Image size 1659x2212. CFP — 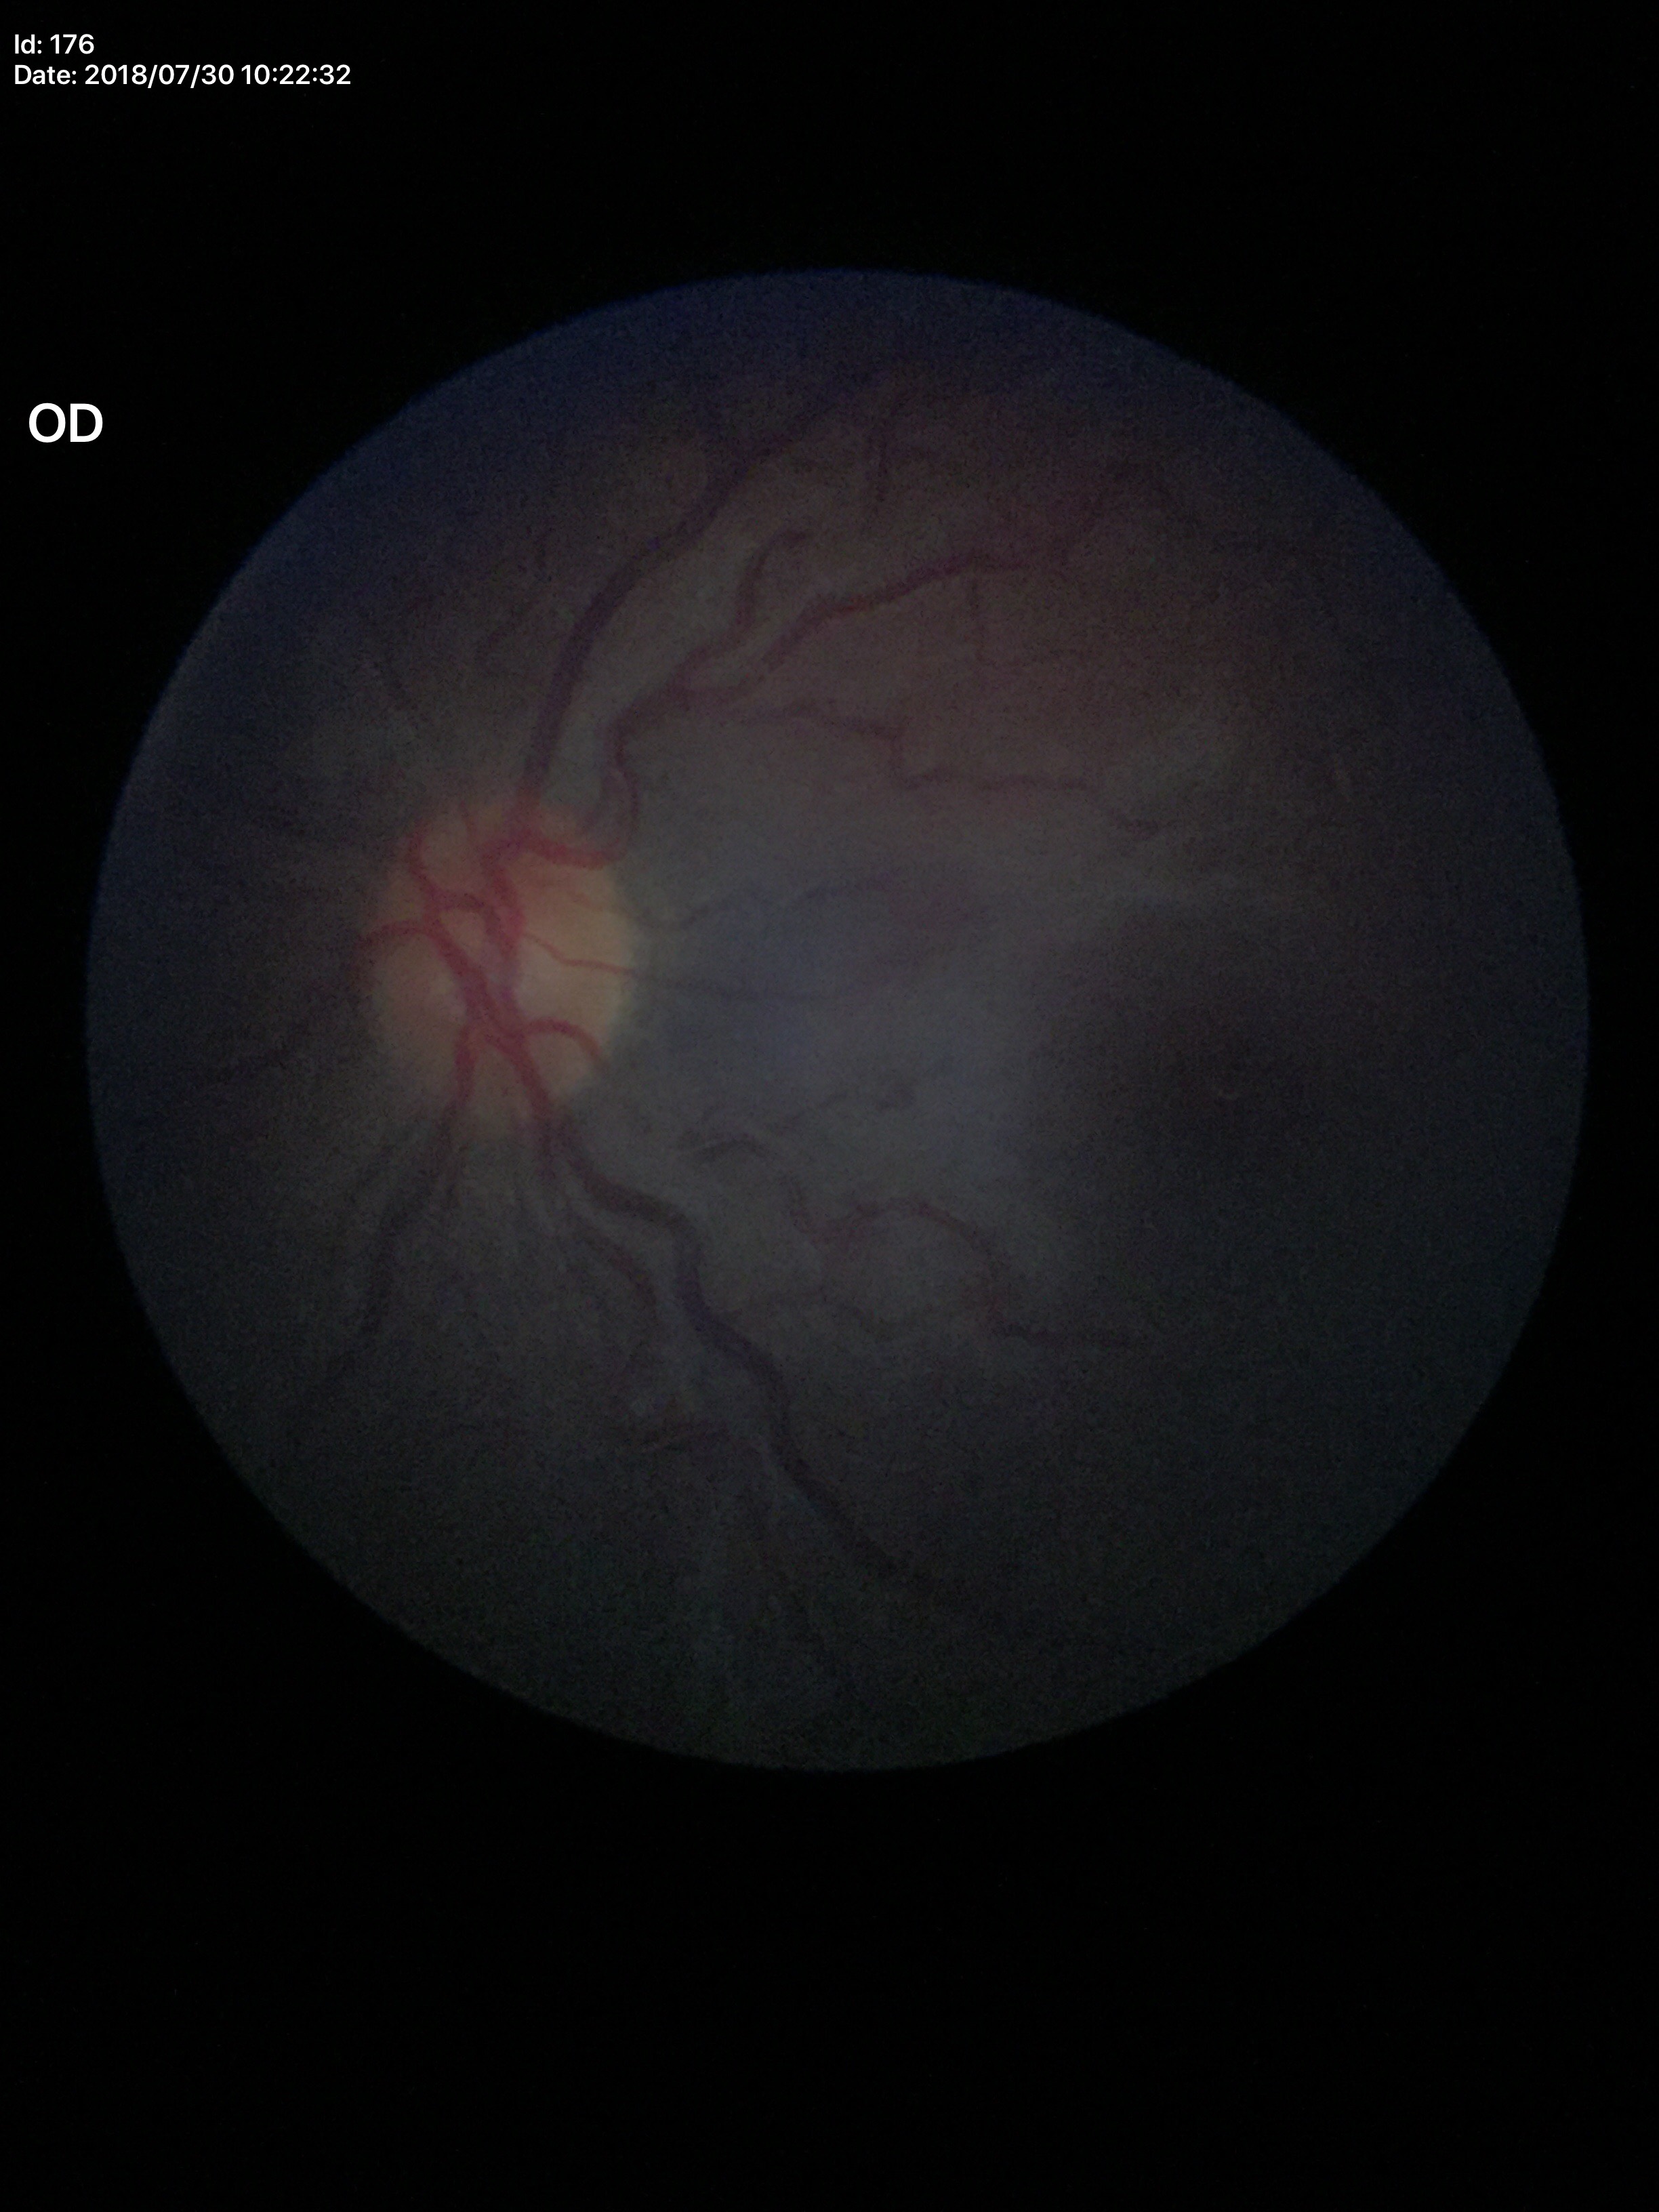
– Glaucoma screening: negative
– vertical CDR (VCDR): 0.46